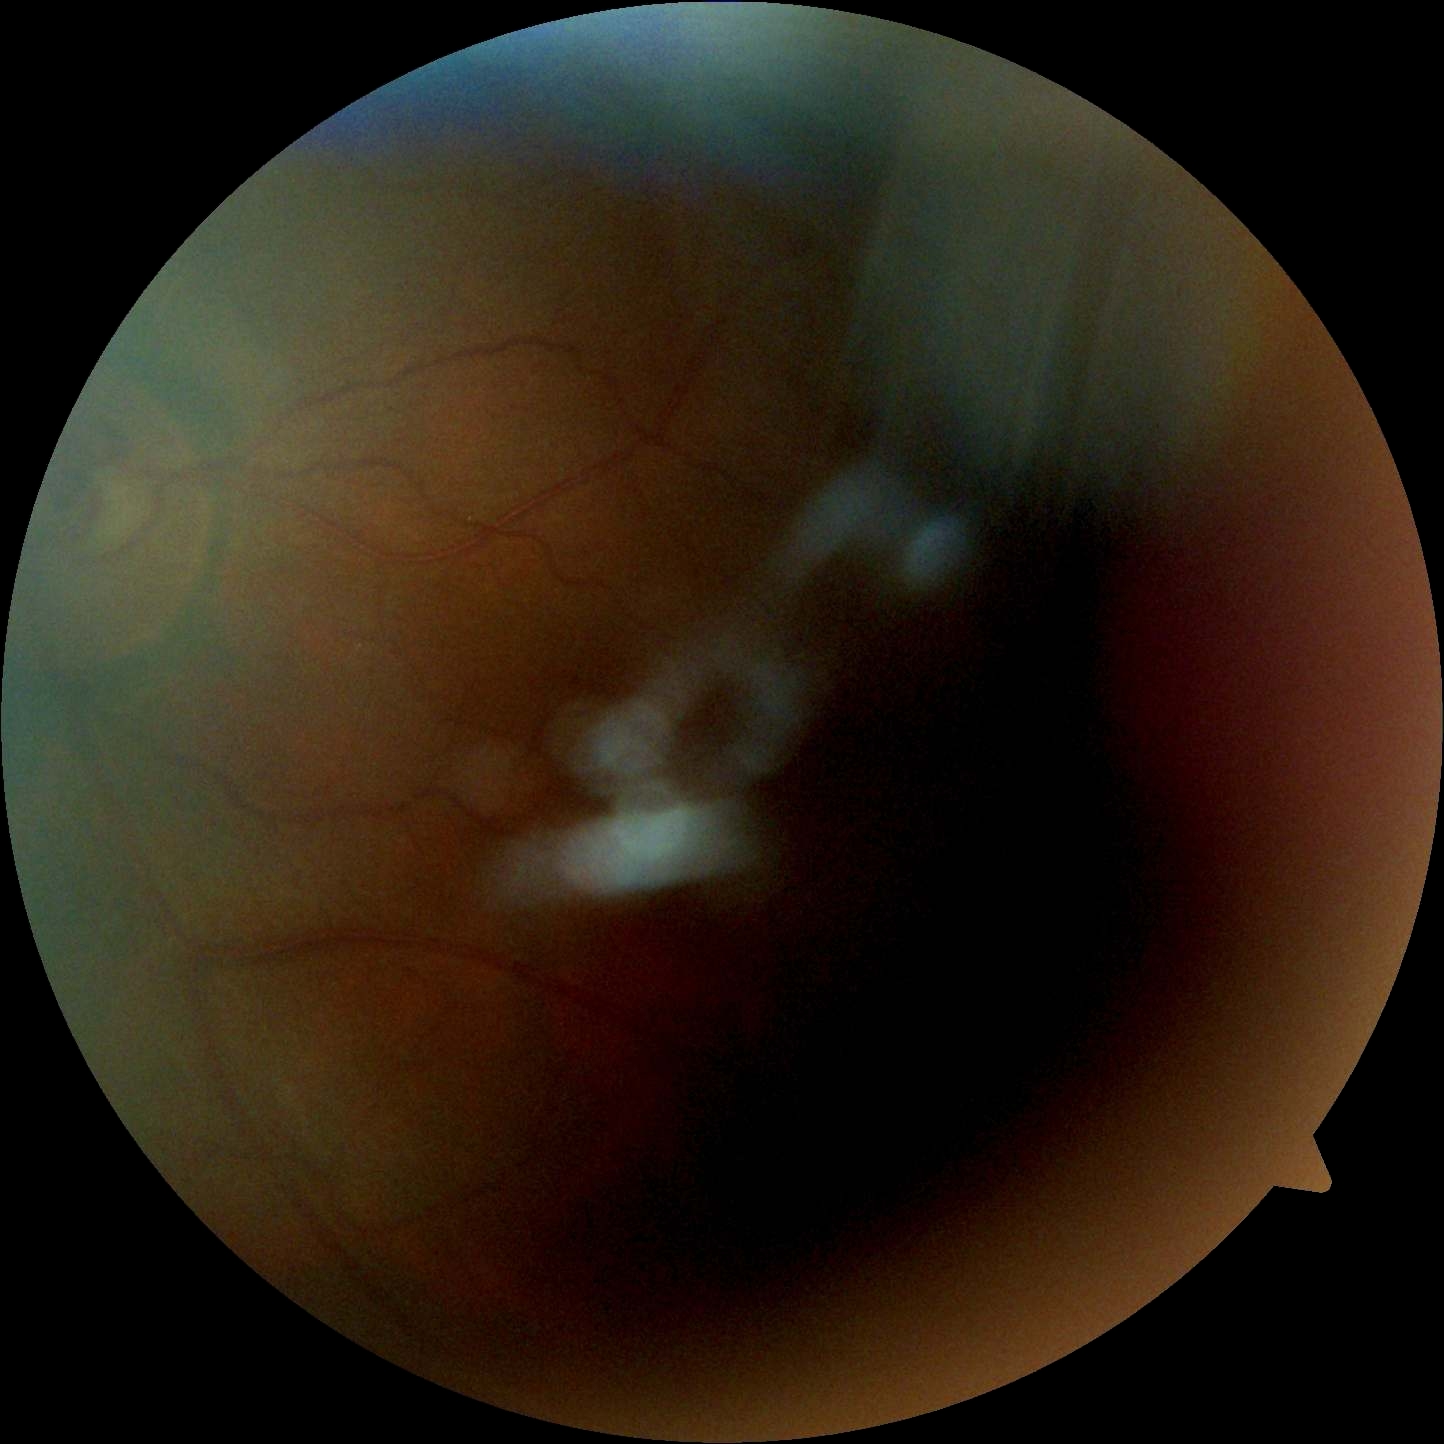 Findings:
* diabetic retinopathy: ungradable